Captured on a Topcon TRC-50DX fundus camera.
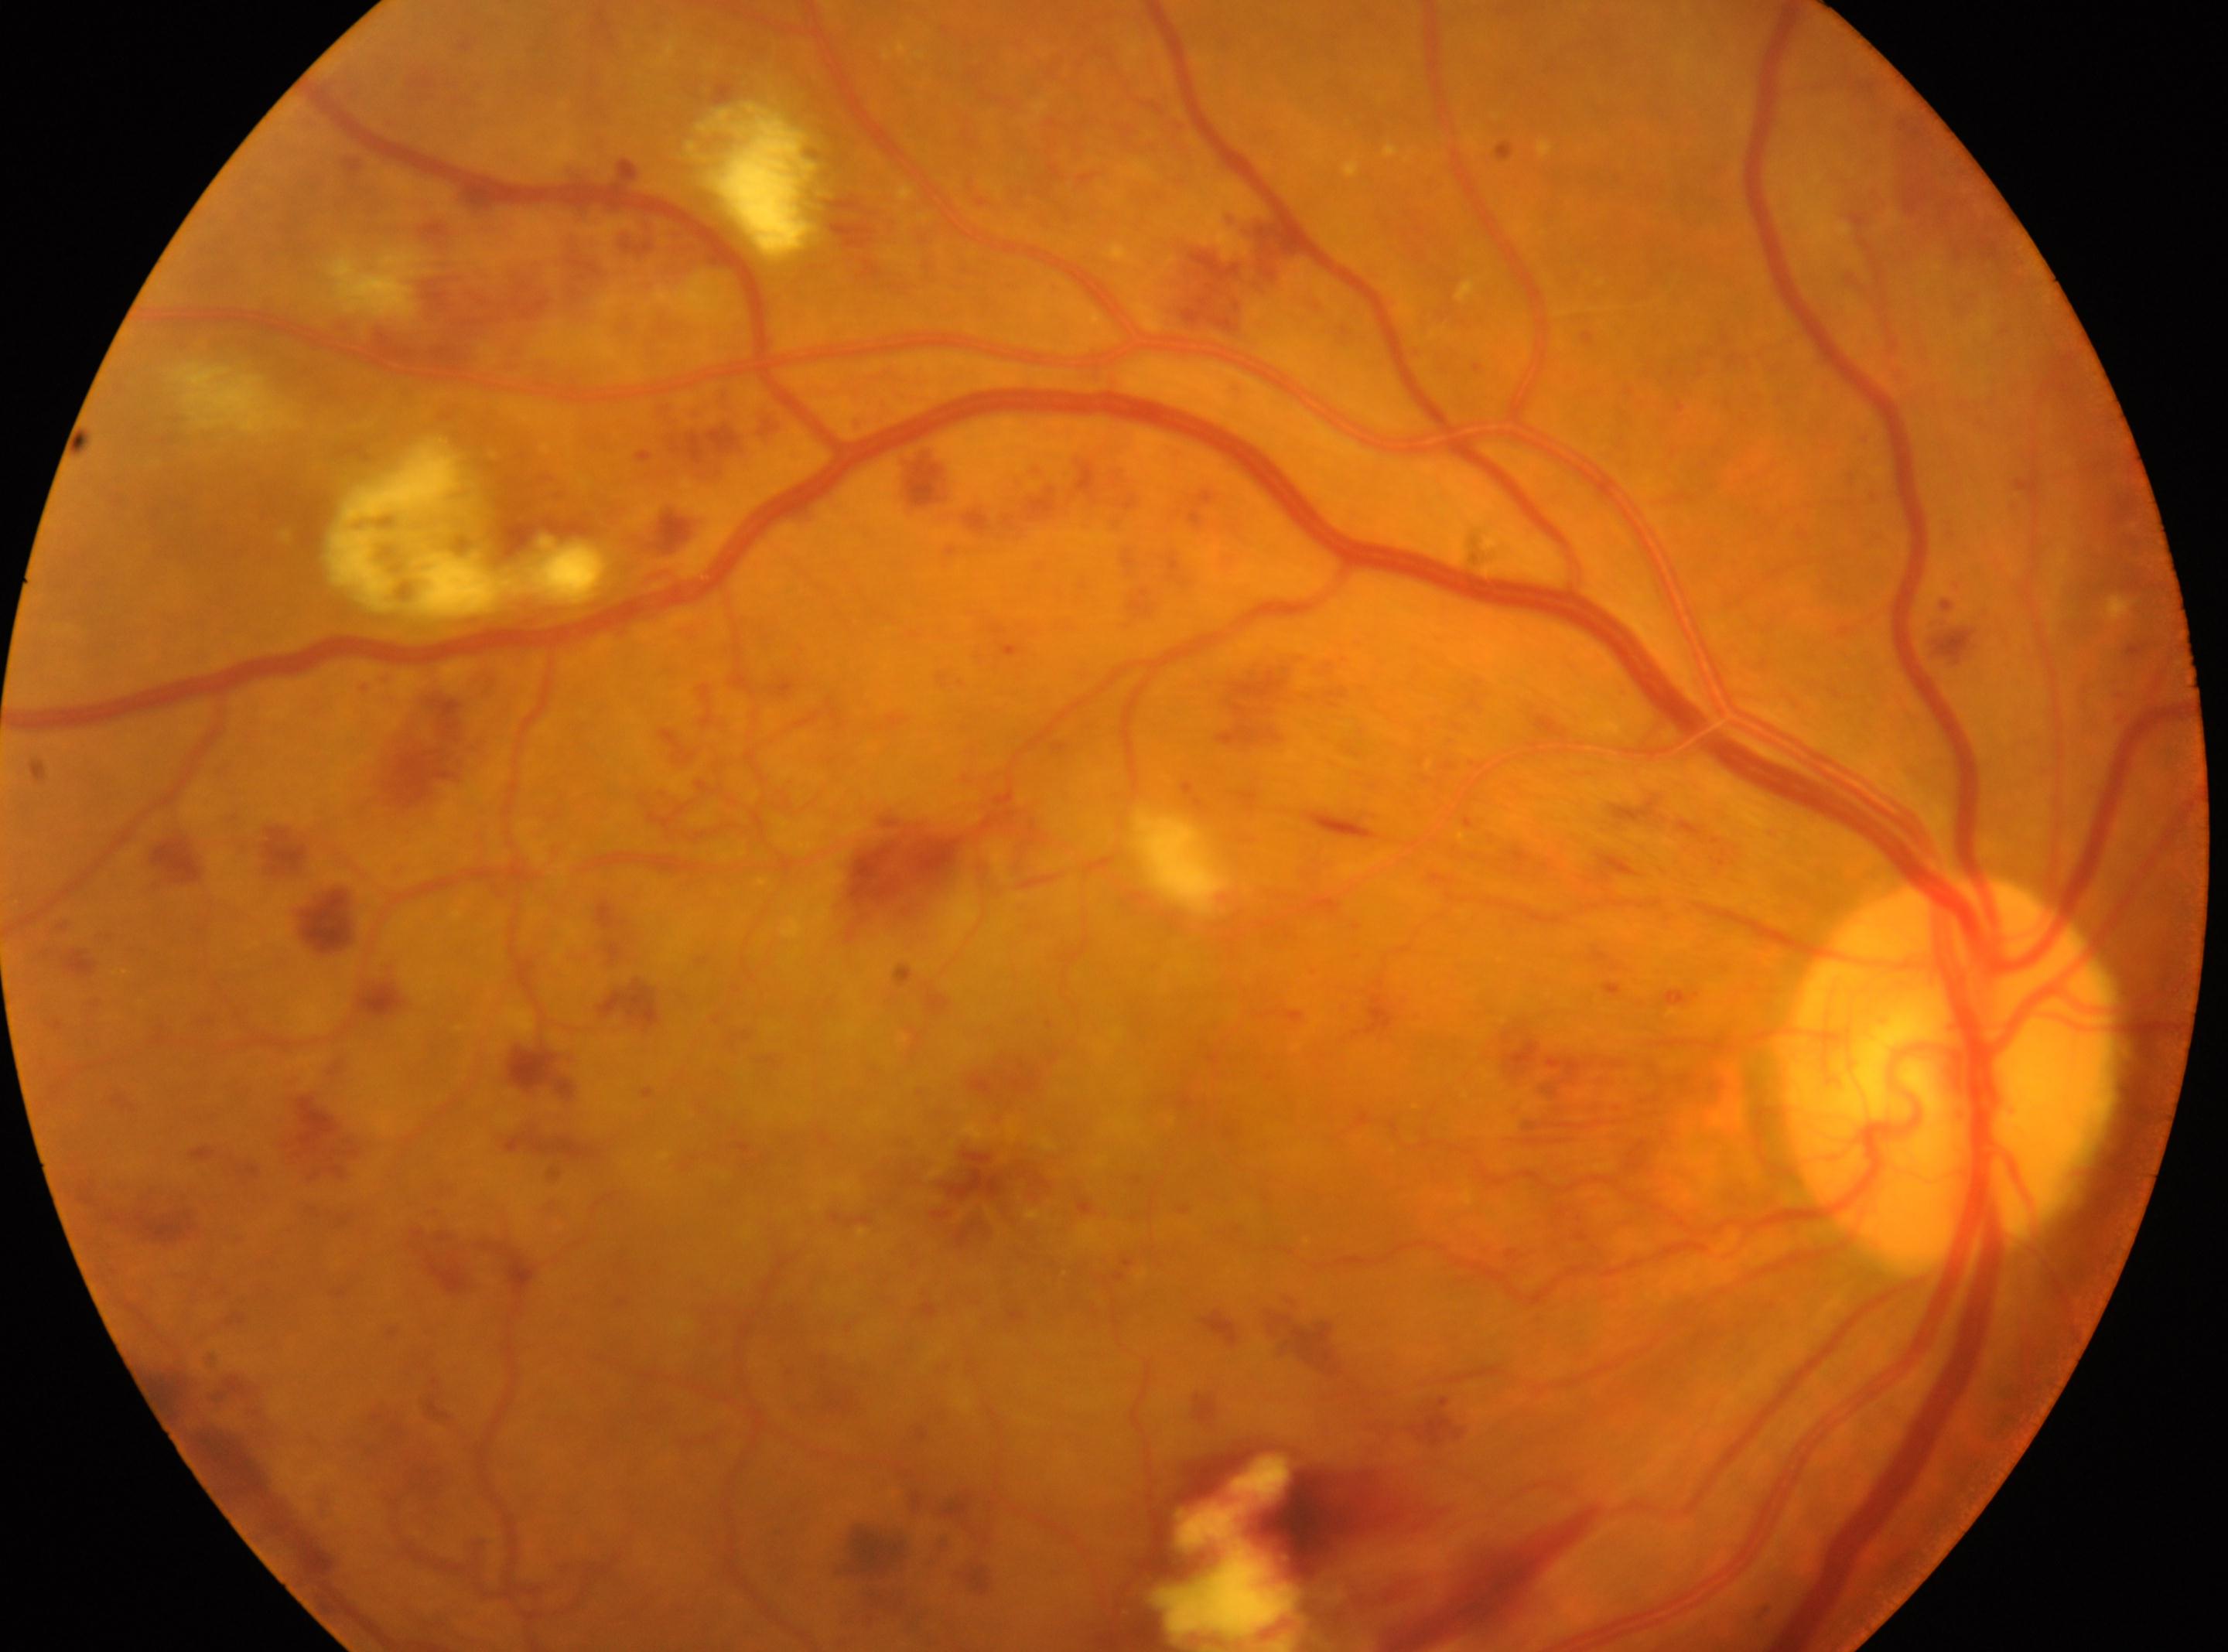
  eye: the right eye
  optic_disc: 1950px, 1069px
  dr_grade: 4 (PDR)
  fovea: 989px, 1165px